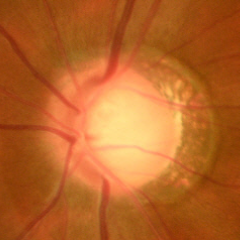 Showing early glaucoma.